DR severity per modified Davis staging; NIDEK AFC-230 fundus camera; color fundus photograph; 45° field of view; nonmydriatic.
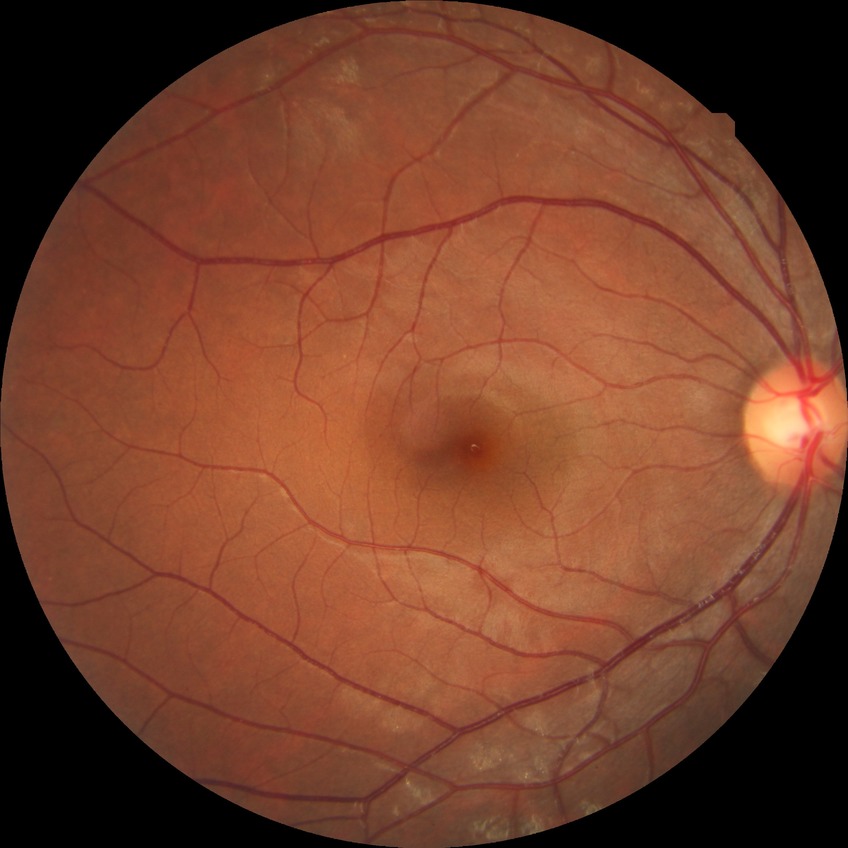 Modified Davis classification is no diabetic retinopathy.